Modified Davis grading — 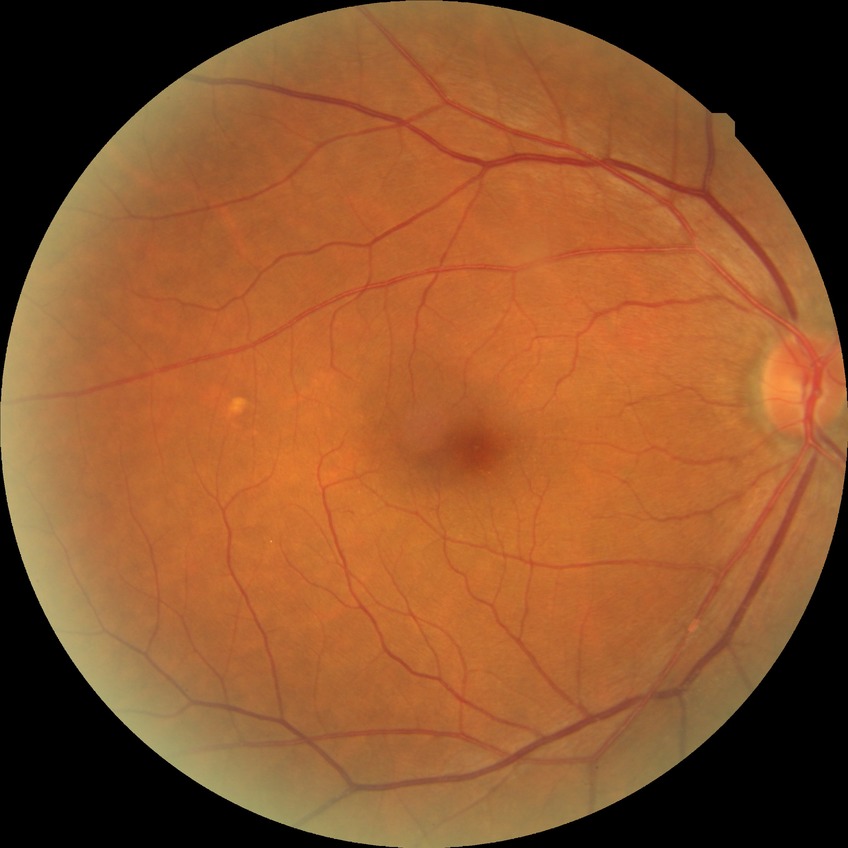 {"davis_grade": "no diabetic retinopathy"}